FOV: 45 degrees; CFP:
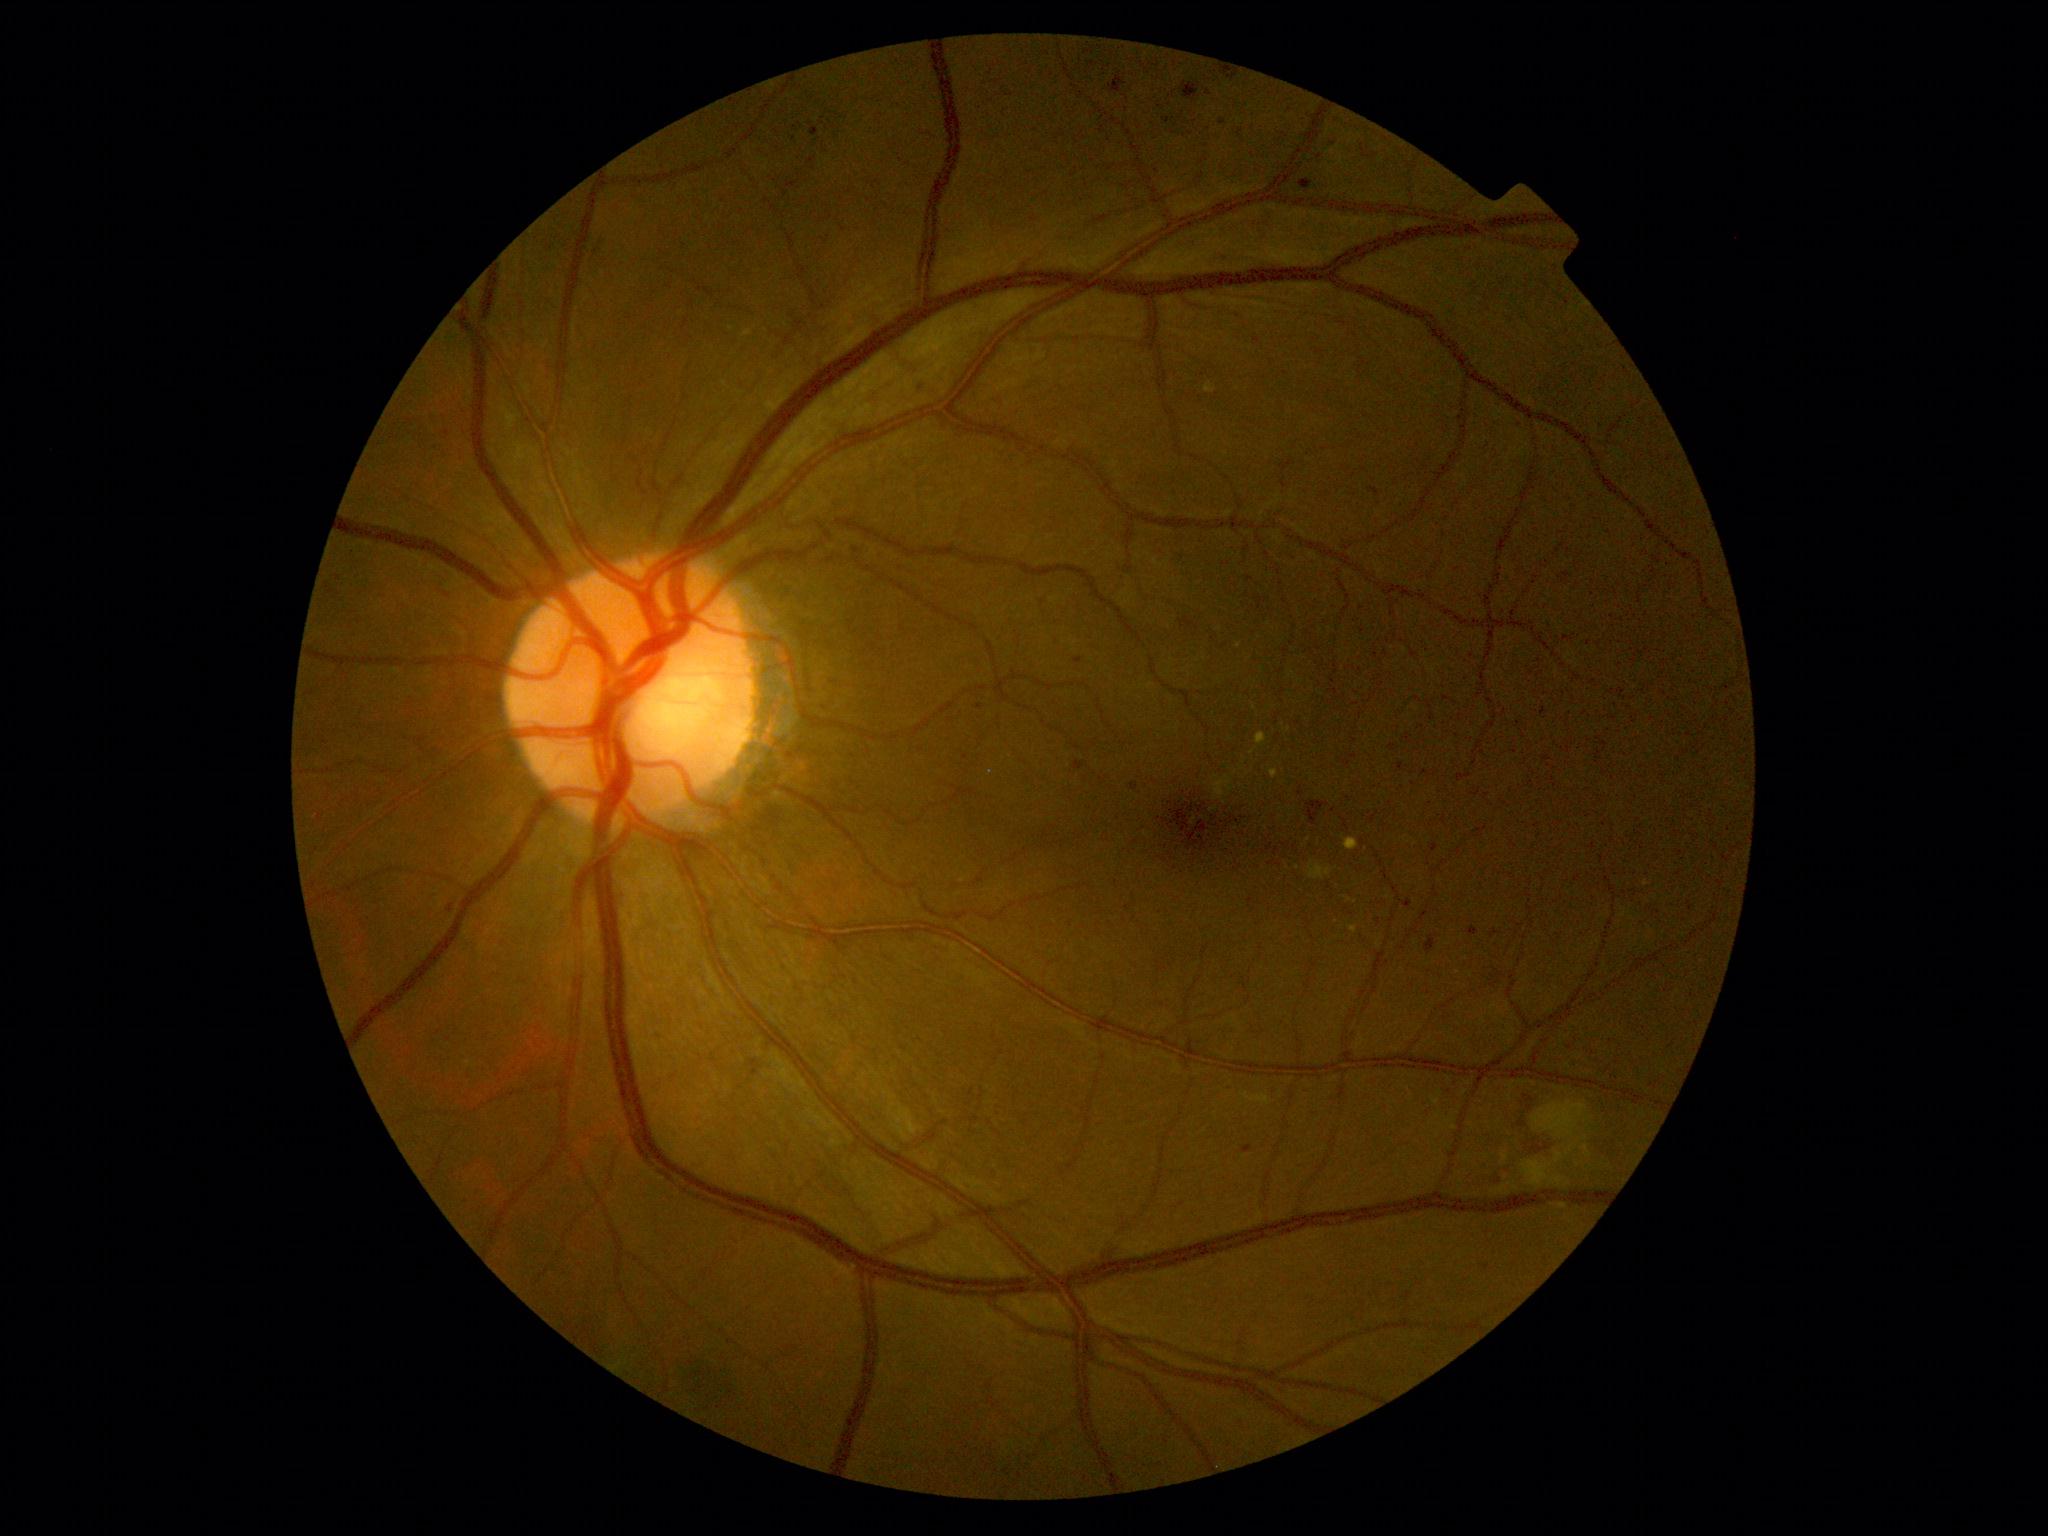
Retinopathy: grade 2. Soft exudates found at [1214, 776, 1234, 799]; [1532, 1101, 1592, 1164]; [1523, 1160, 1565, 1187]; [1308, 862, 1333, 881]. Microaneurysms include [1368, 488, 1380, 497]; [1426, 935, 1438, 954]; [976, 704, 984, 710]; [1222, 71, 1238, 80]; [811, 127, 820, 138]; [1397, 763, 1404, 772]; [1430, 843, 1439, 852]; [1181, 83, 1201, 102]; [1075, 657, 1083, 664]; [1559, 573, 1570, 583]. Small microaneurysms approximately at [921, 389]; [1222, 122]; [1208, 94]; [549, 247]; [1486, 1268]. Hemorrhages found at [589, 239, 603, 256]; [1527, 1144, 1546, 1157]; [1516, 1101, 1532, 1130]; [1307, 802, 1330, 826]. Hard exudates found at [1257, 733, 1268, 746]; [1348, 926, 1358, 934]; [1344, 838, 1360, 851]; [1269, 769, 1278, 779]. Small hard exudates approximately at [1379, 945].